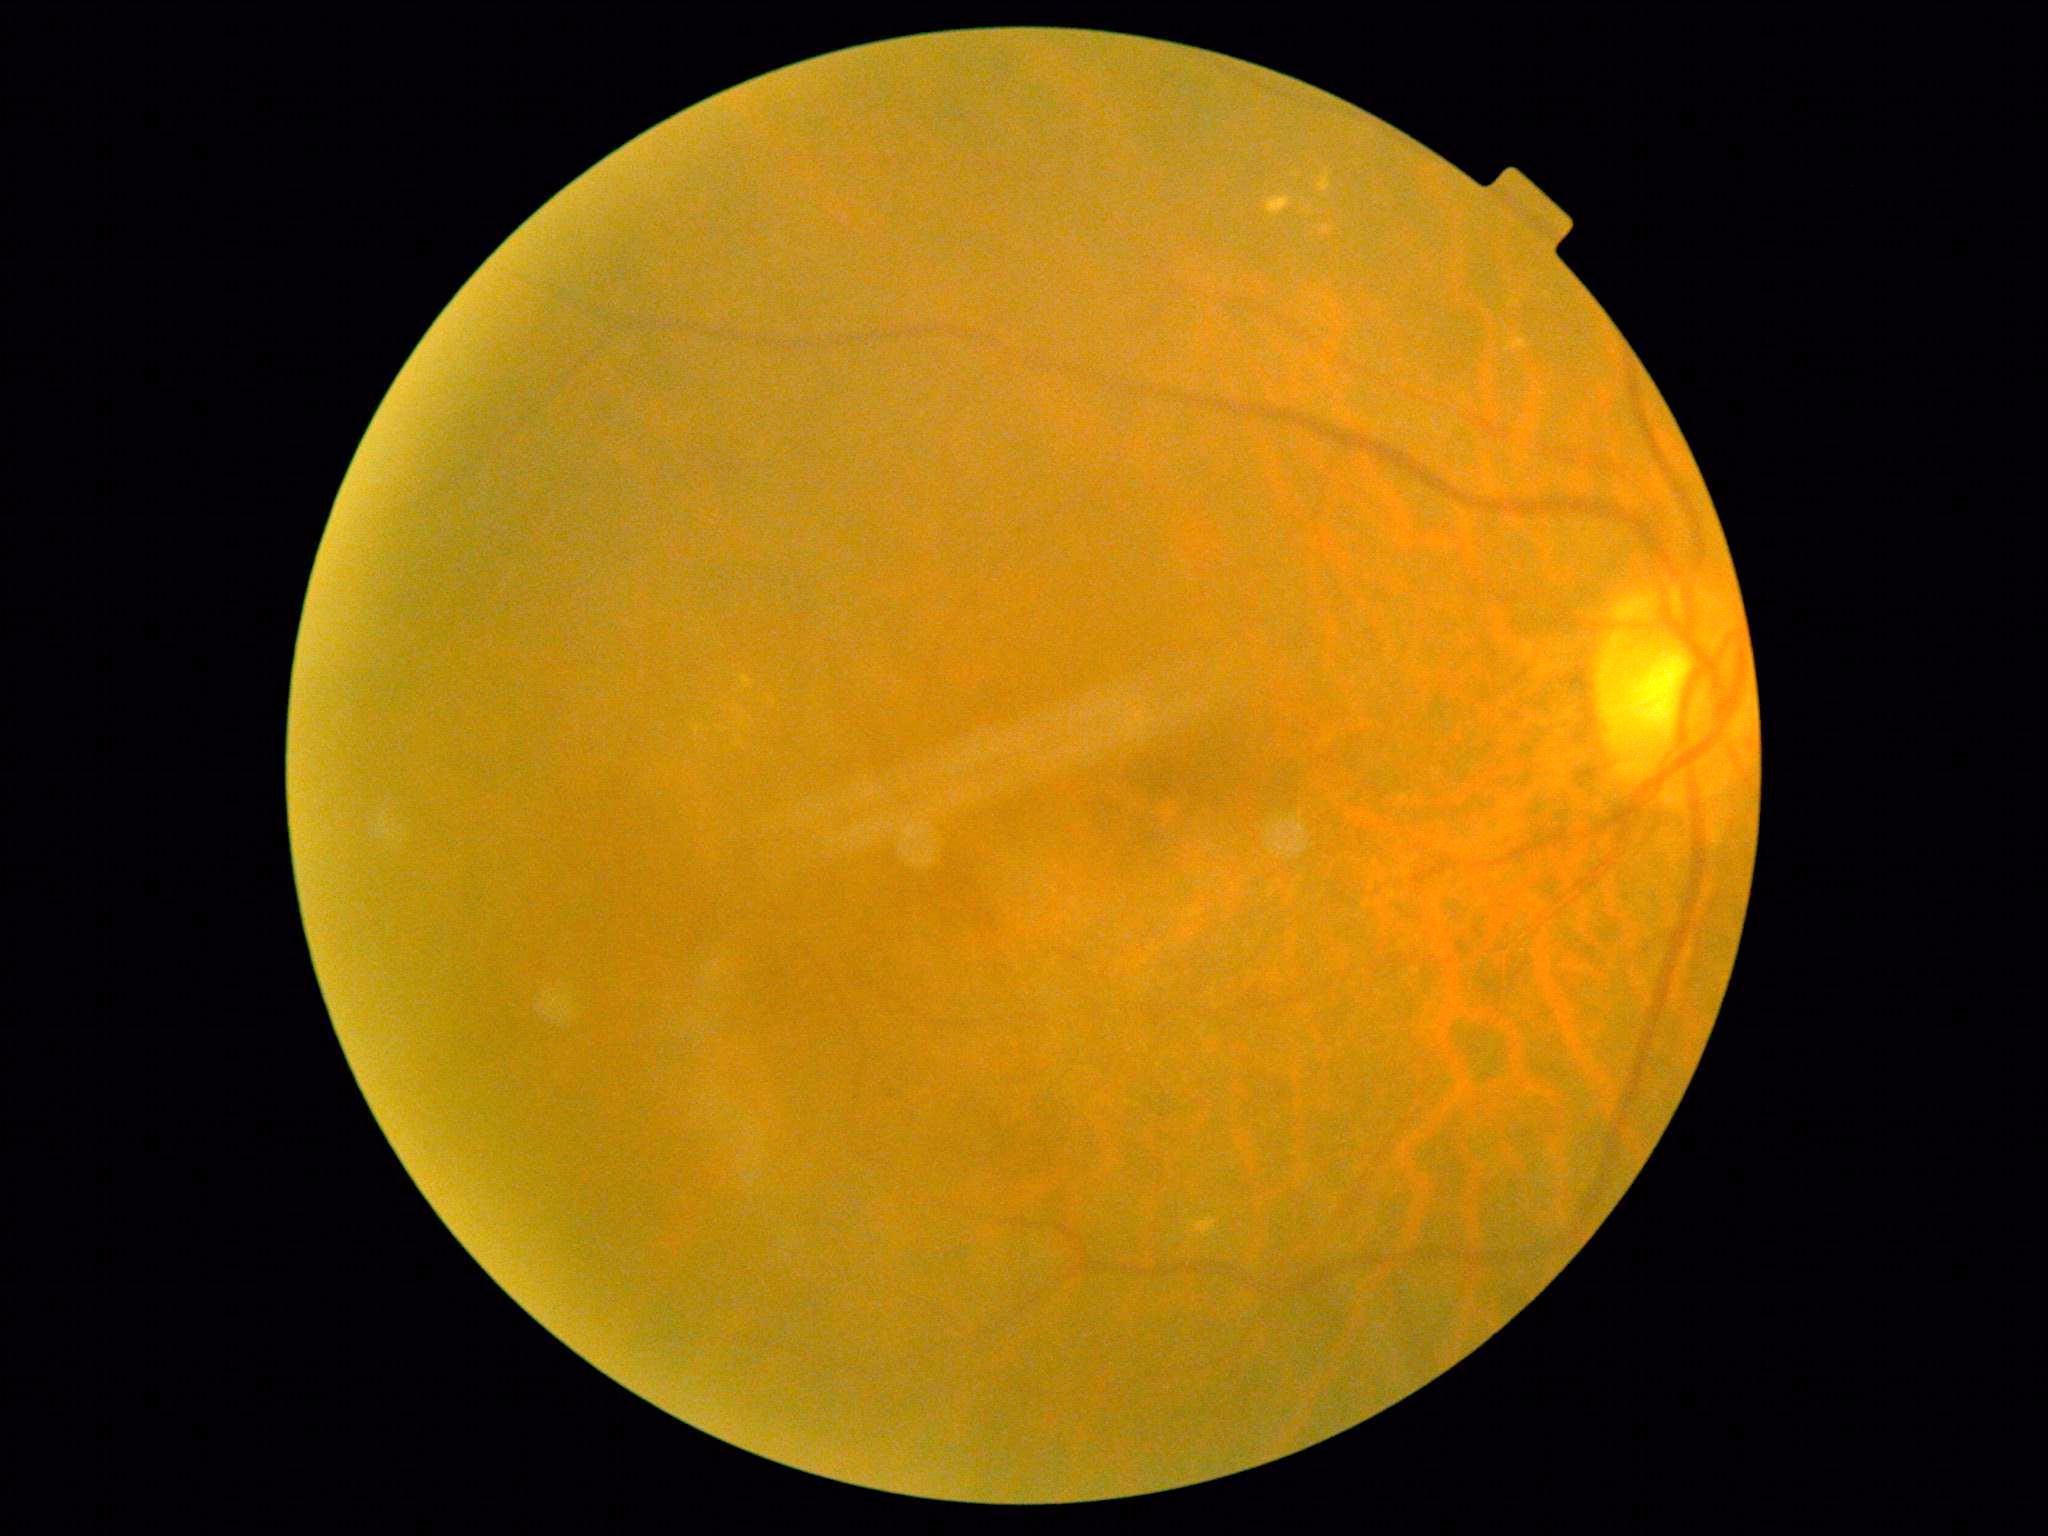 DR grade: 2.